Color fundus photograph, 848 by 848 pixels
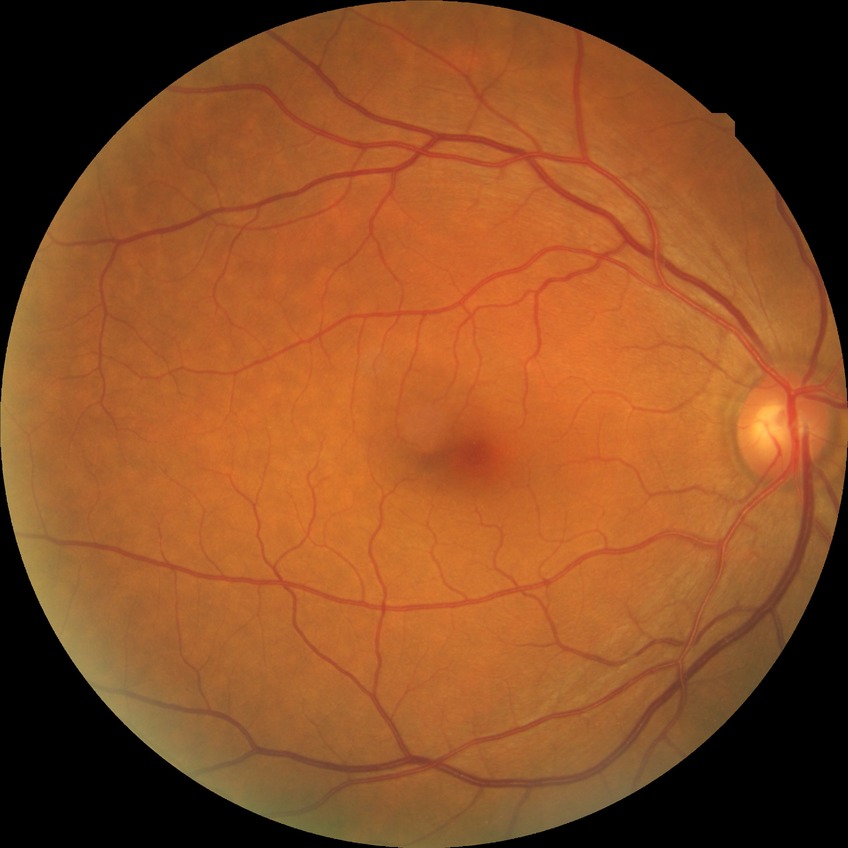 Diabetic retinopathy (DR) is no diabetic retinopathy (NDR).